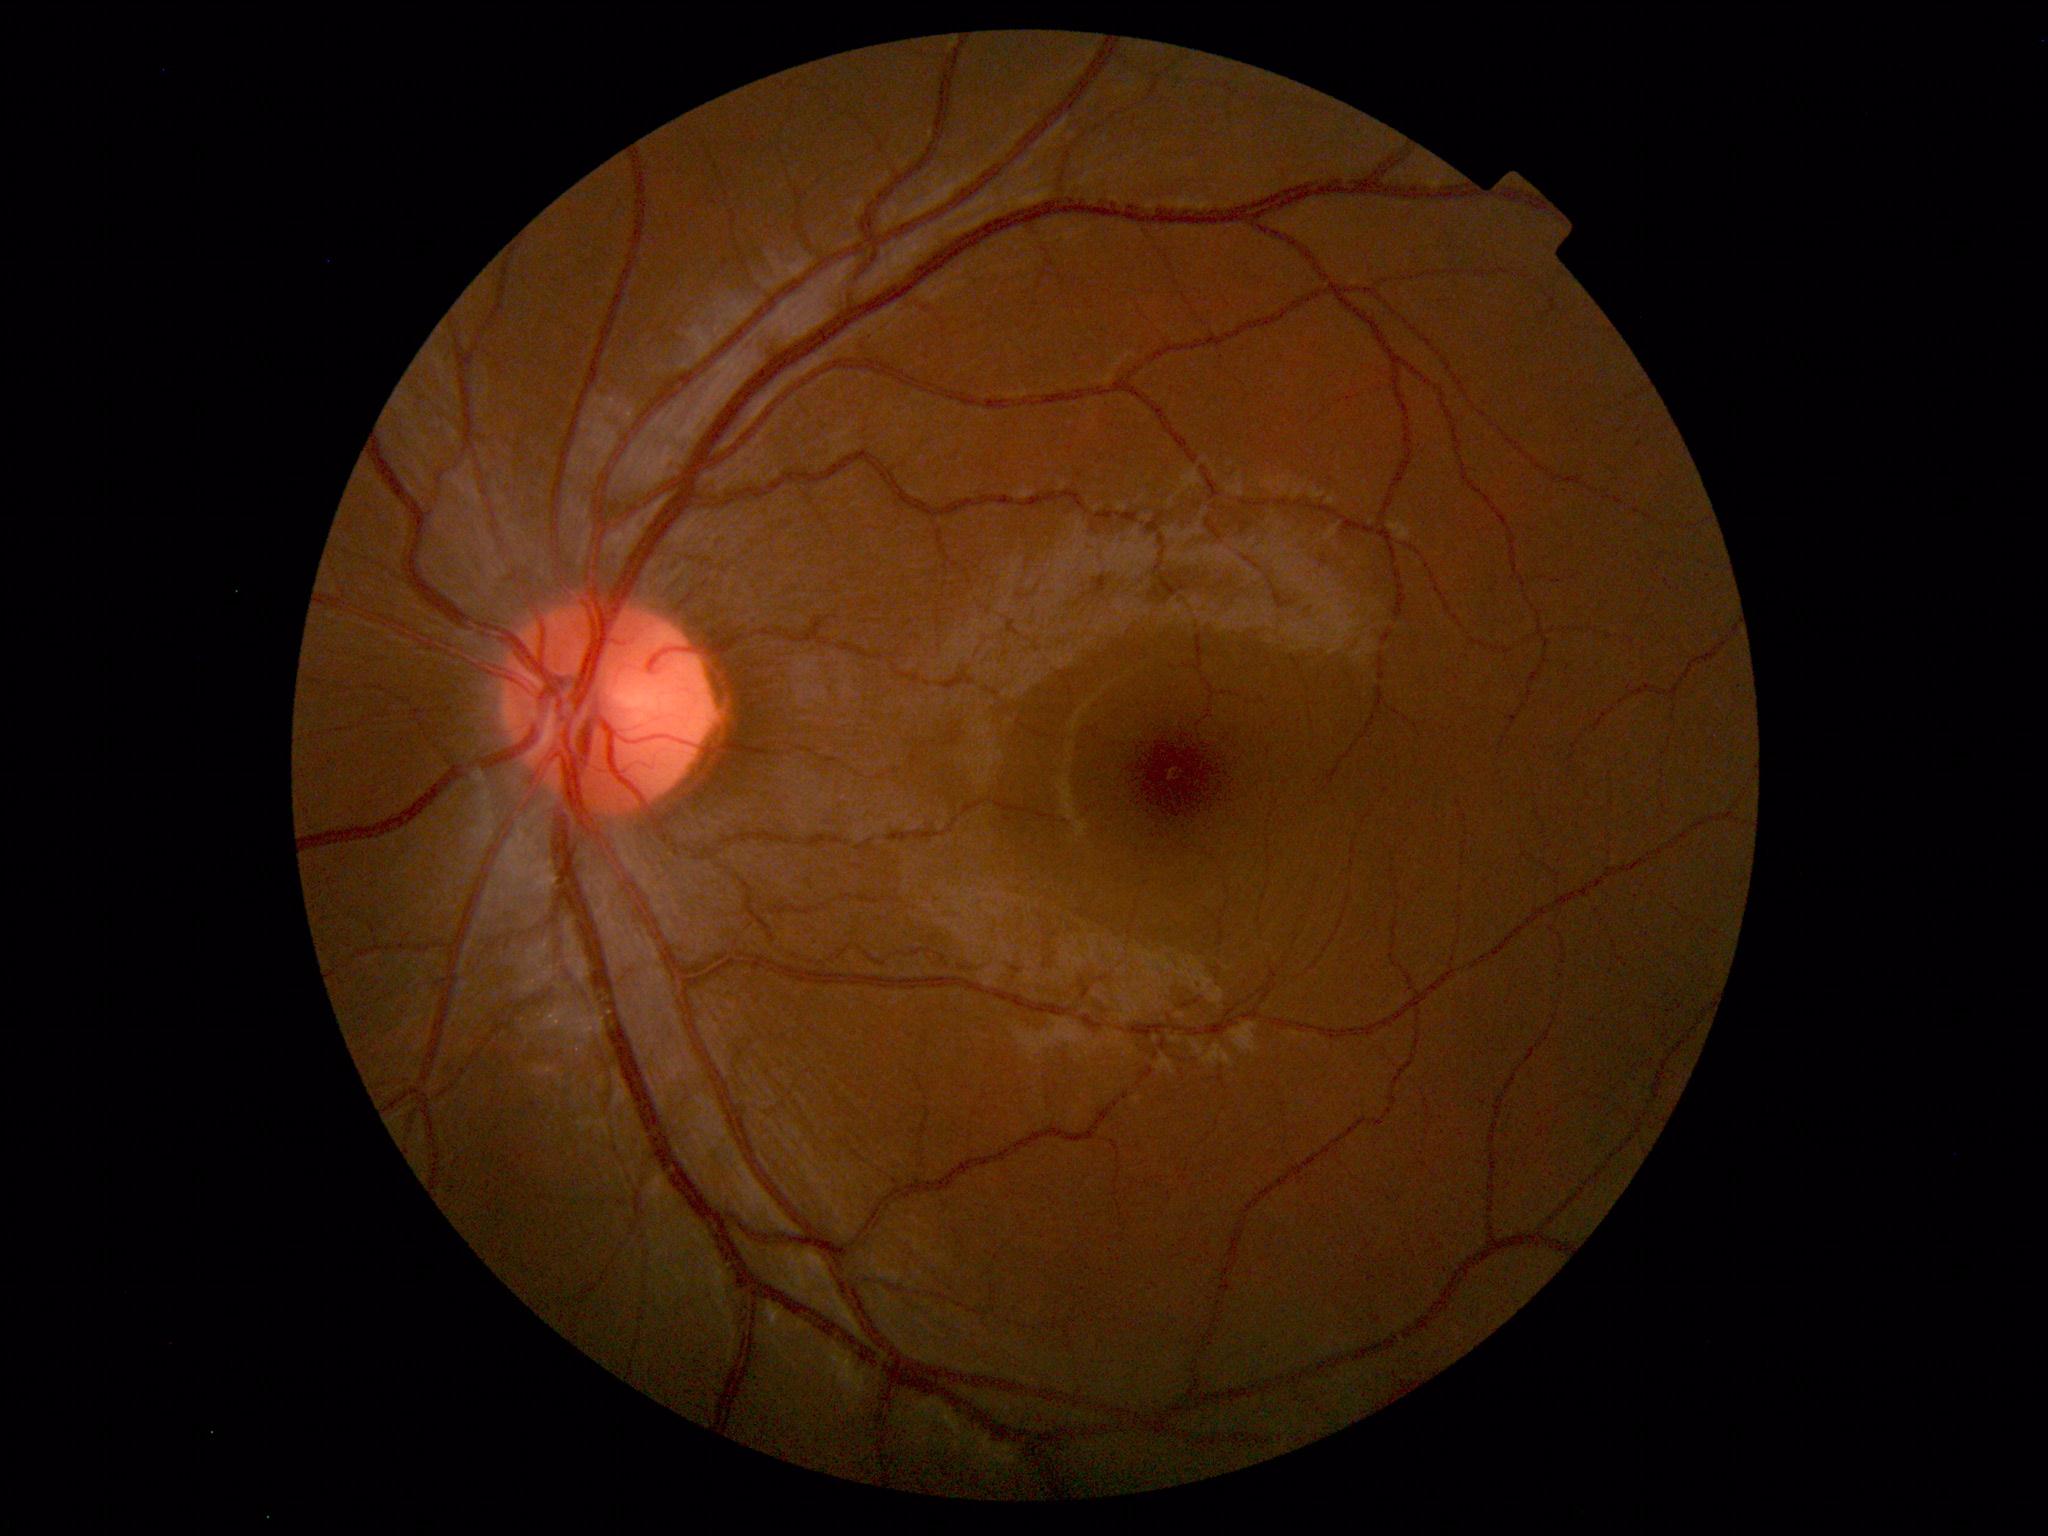

Findings: none. Normal fundus.